45° FOV
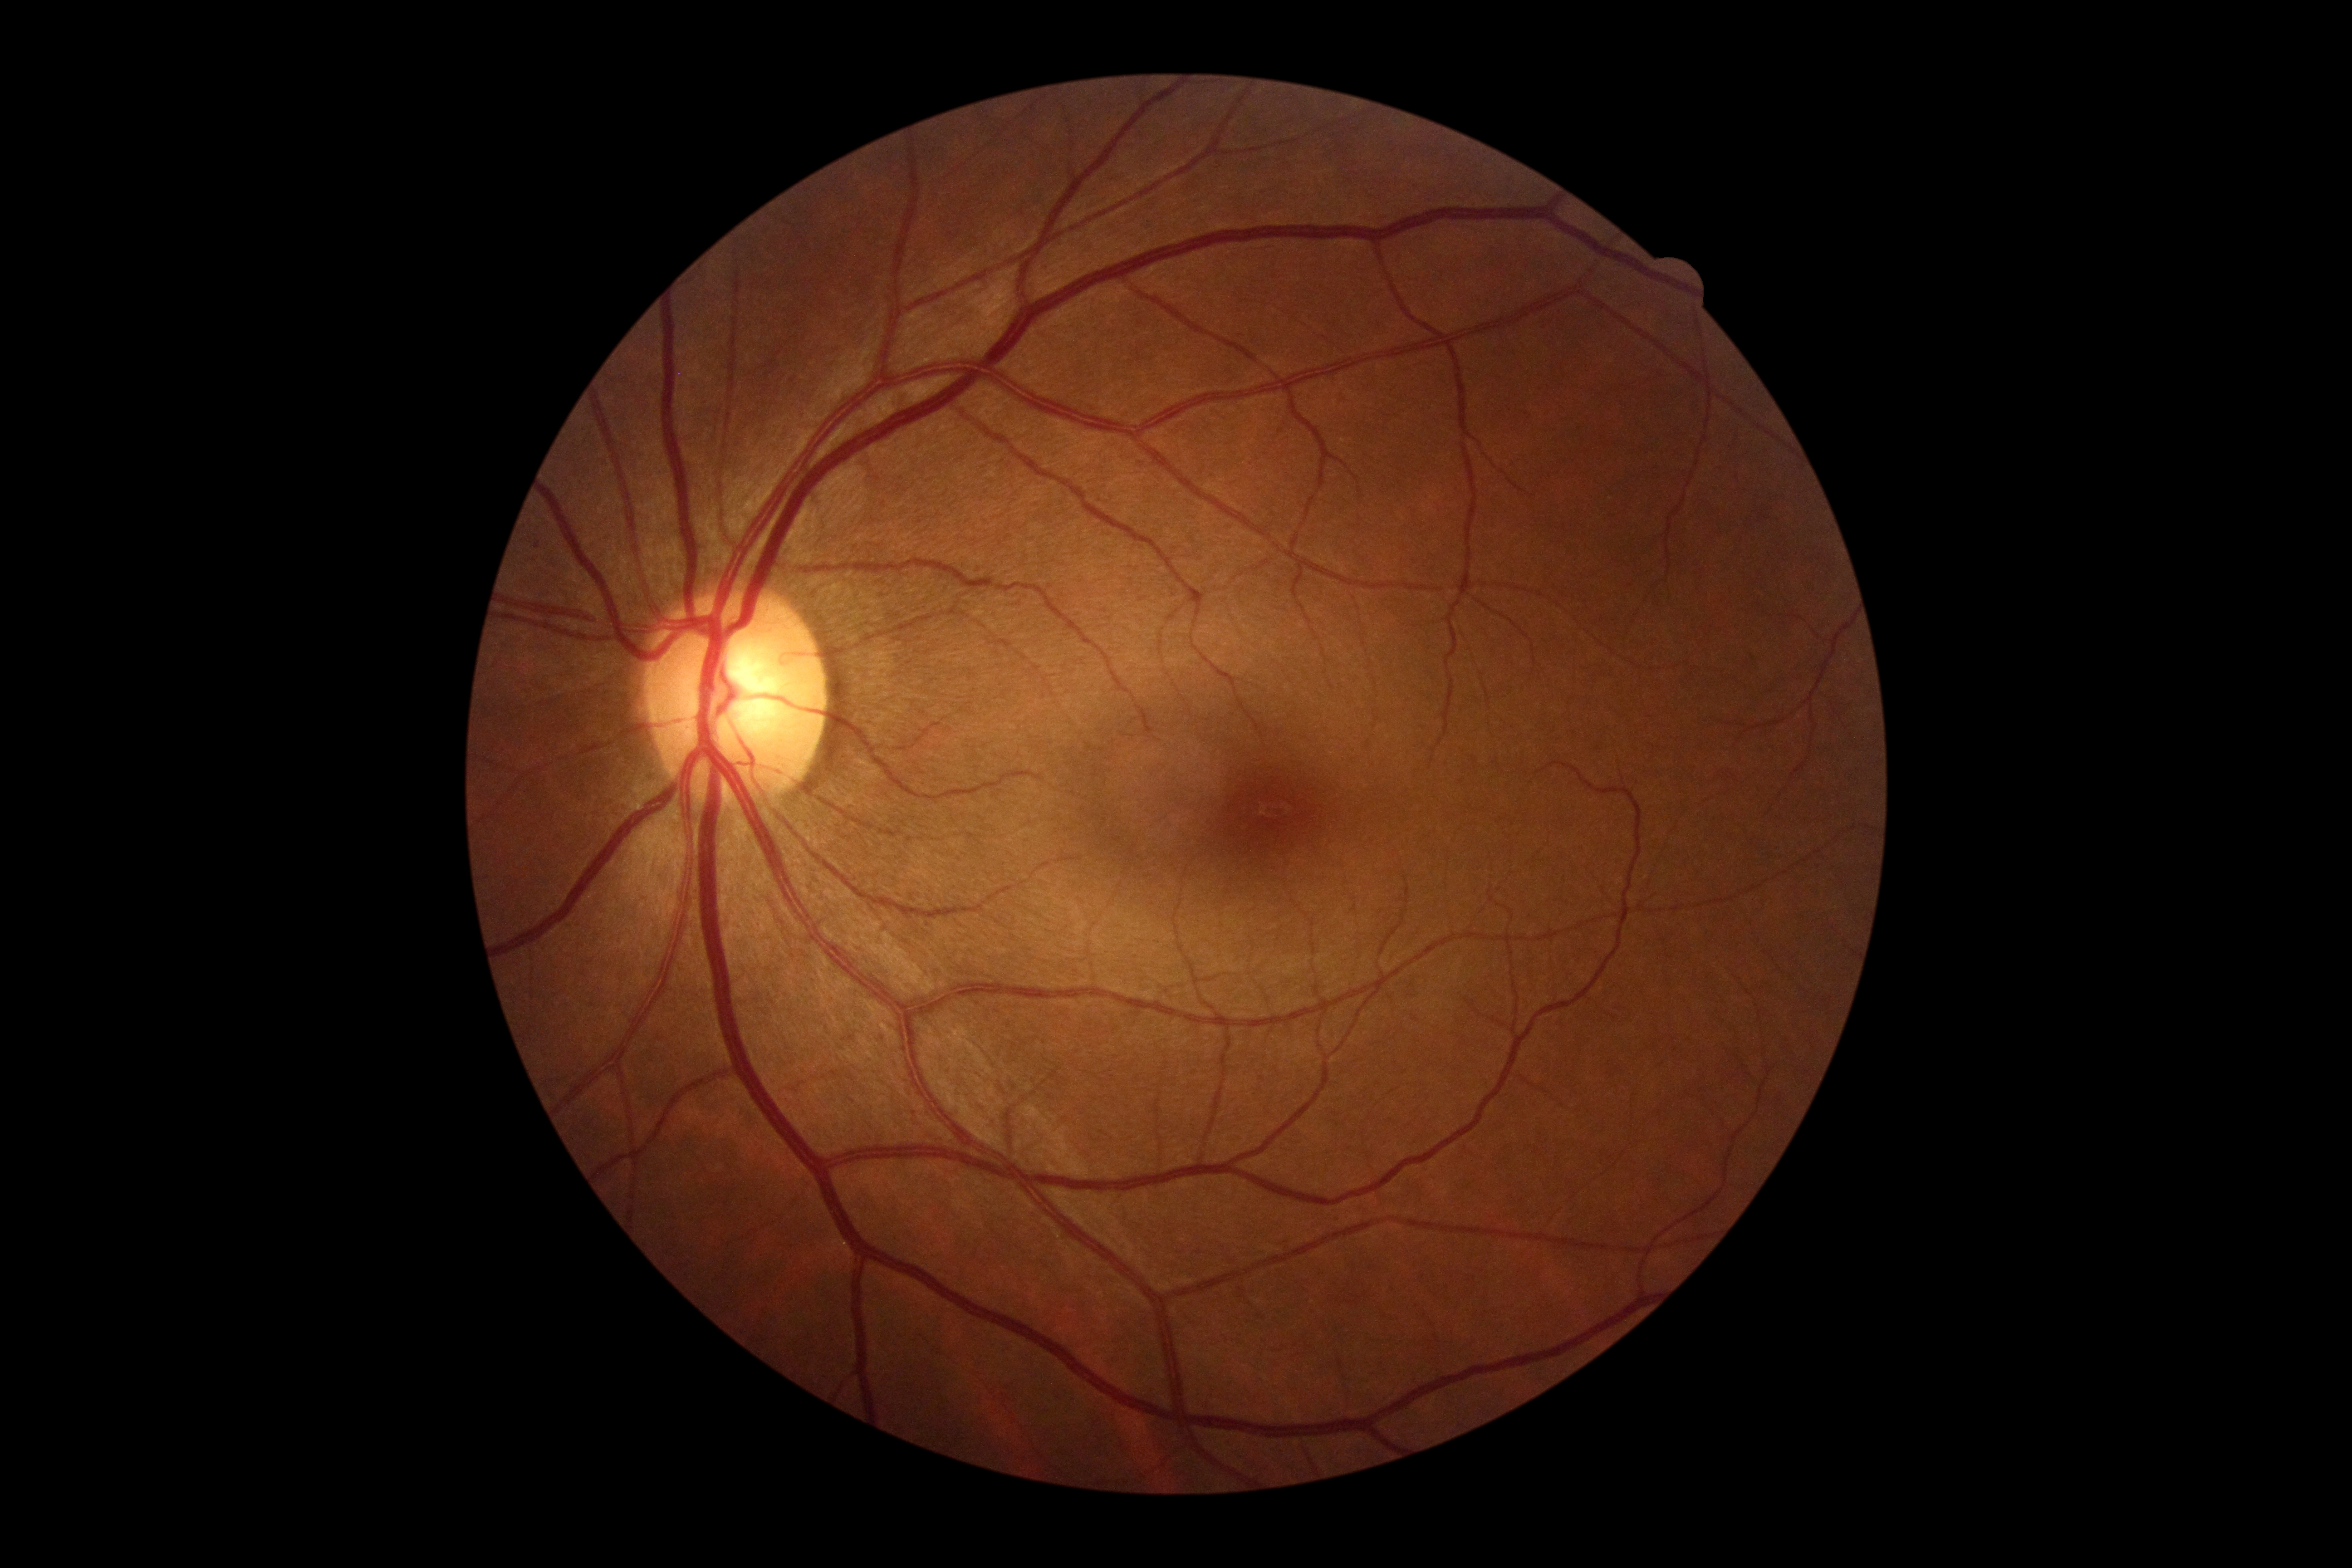
Diabetic retinopathy (DR): grade 0 (no apparent retinopathy). No diabetic retinal disease findings.